Camera: NIDEK AFC-230:
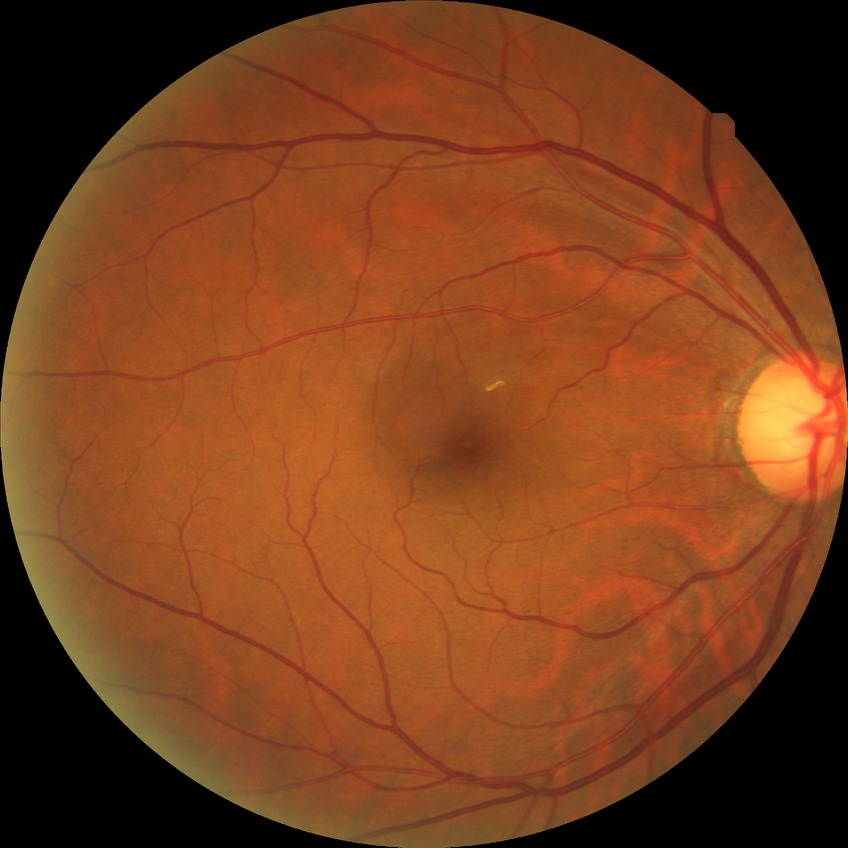
Modified Davis grading is no diabetic retinopathy.